45° field of view — 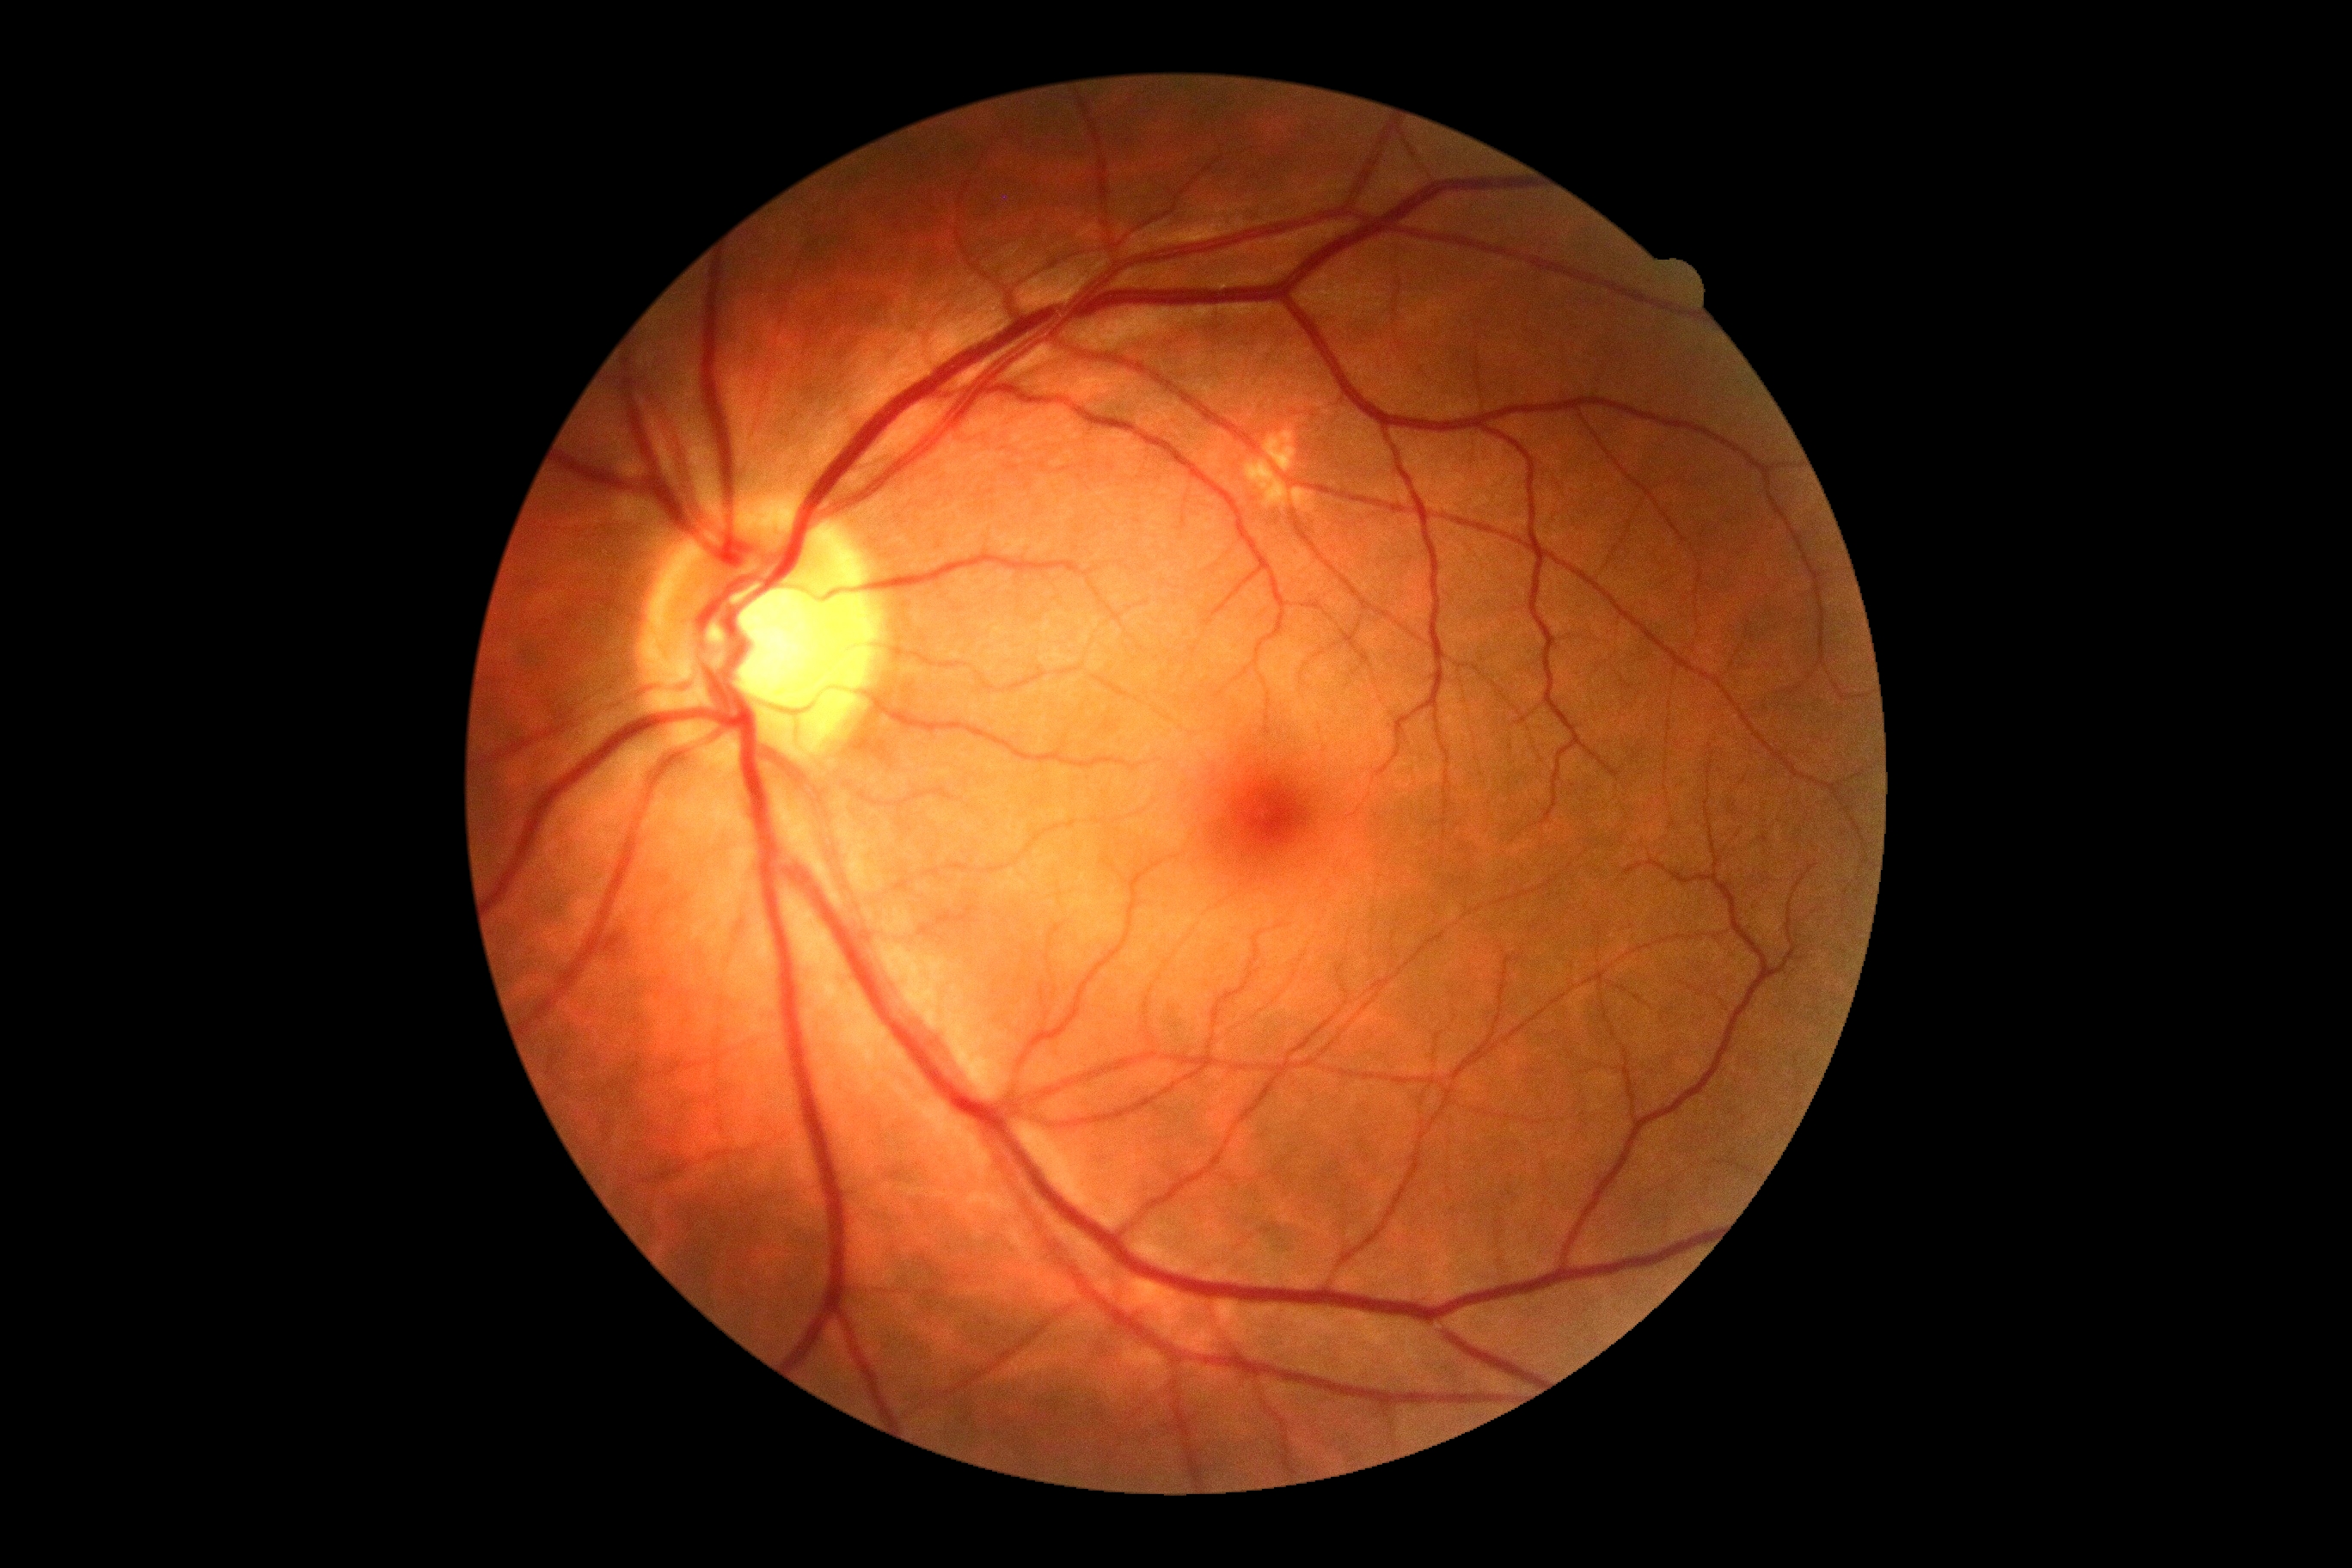
diabetic retinopathy (DR) = grade 0 (no apparent retinopathy).